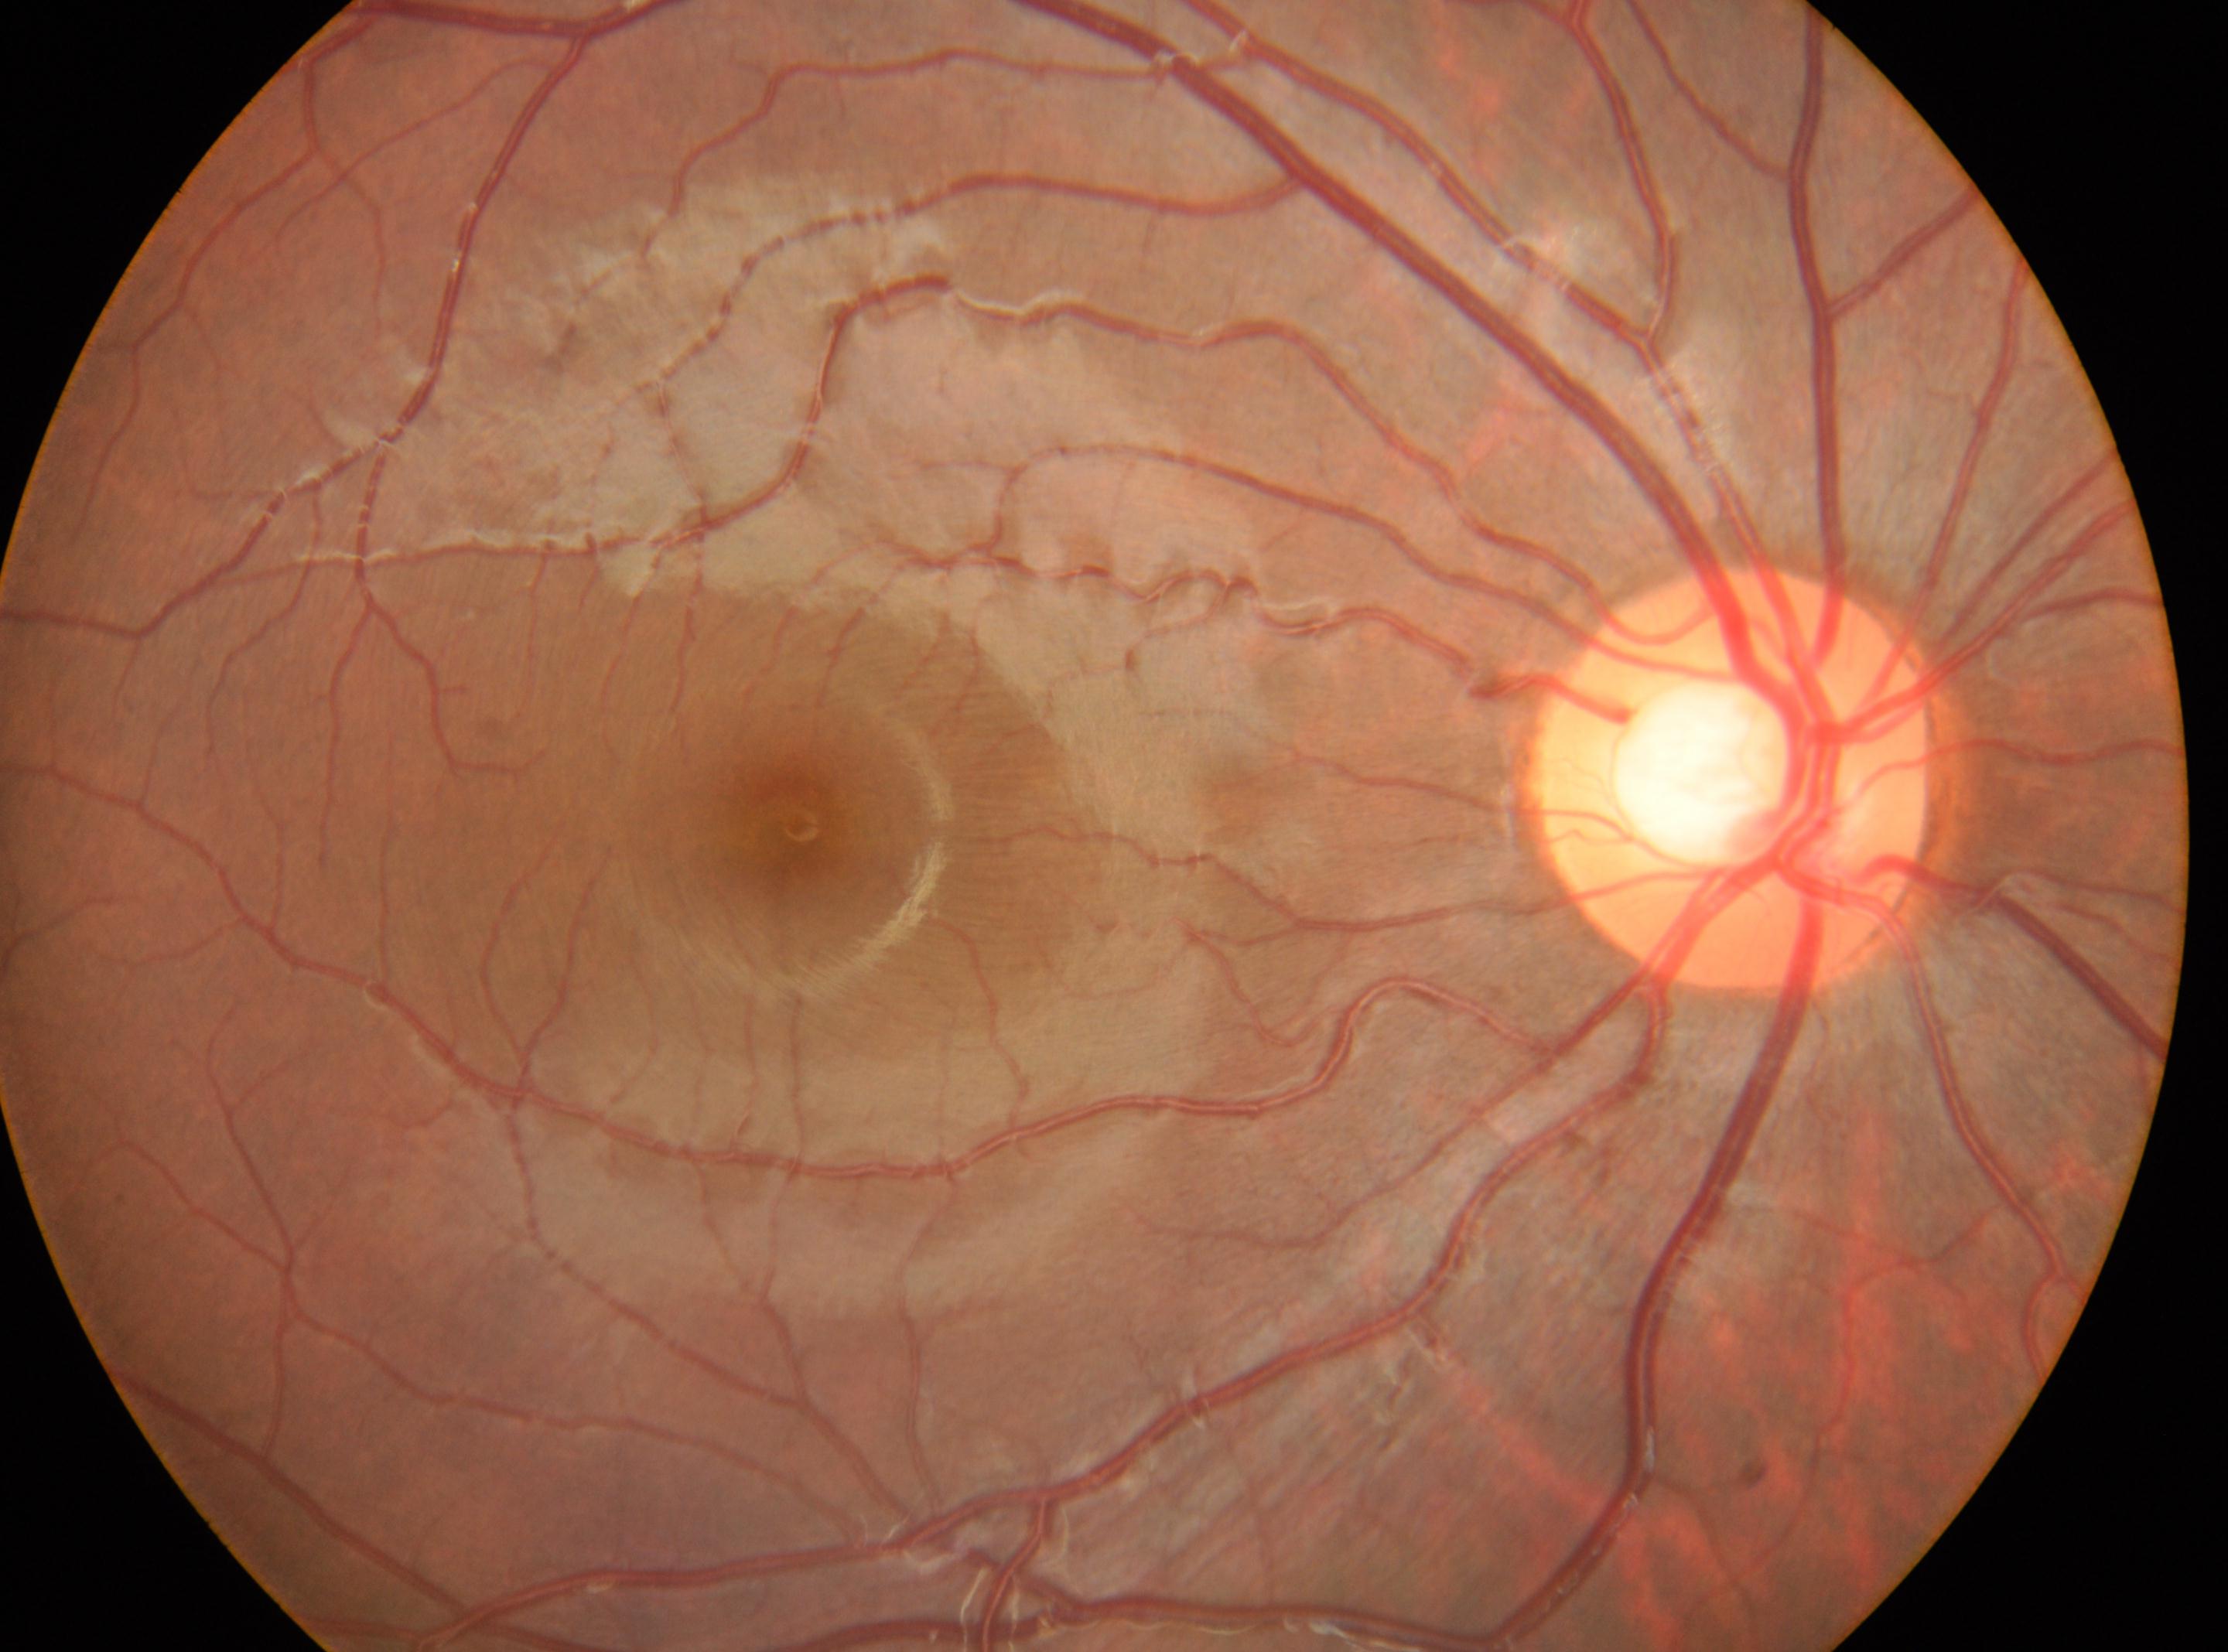
Diabetic retinopathy (DR) is 0/4. No DR findings. The foveal center is at [795, 823]. This is the right eye. The ONH is at [1734, 775].